No pharmacologic dilation, camera: NIDEK AFC-230.
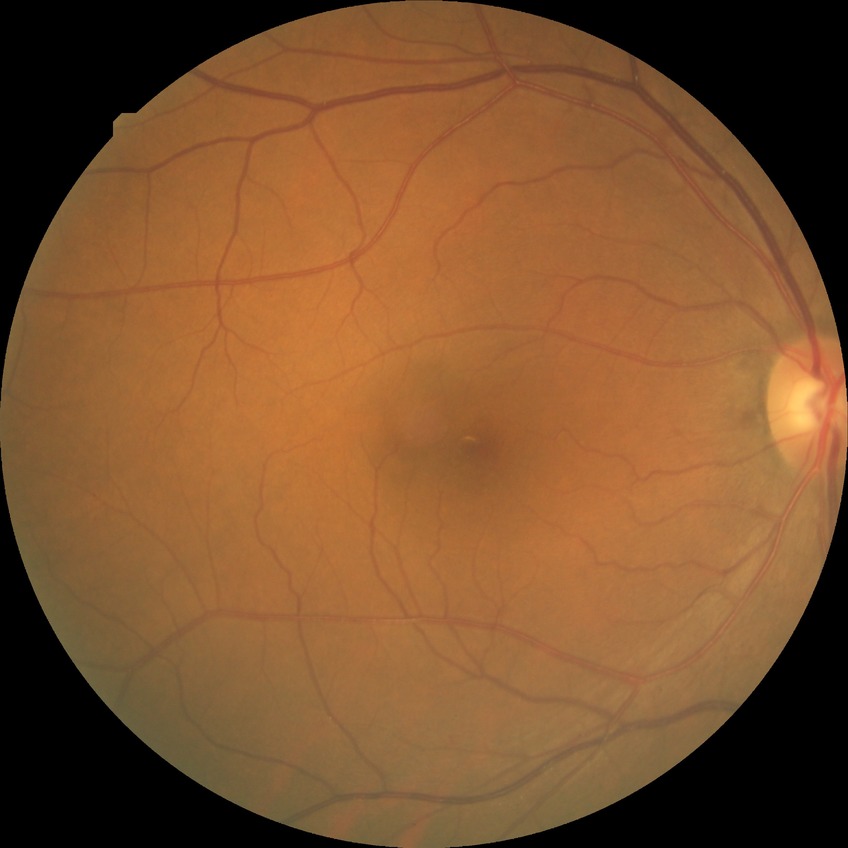
davis_grade: no diabetic retinopathy (NDR)